1440x1080. Wide-field fundus photograph from neonatal ROP screening — 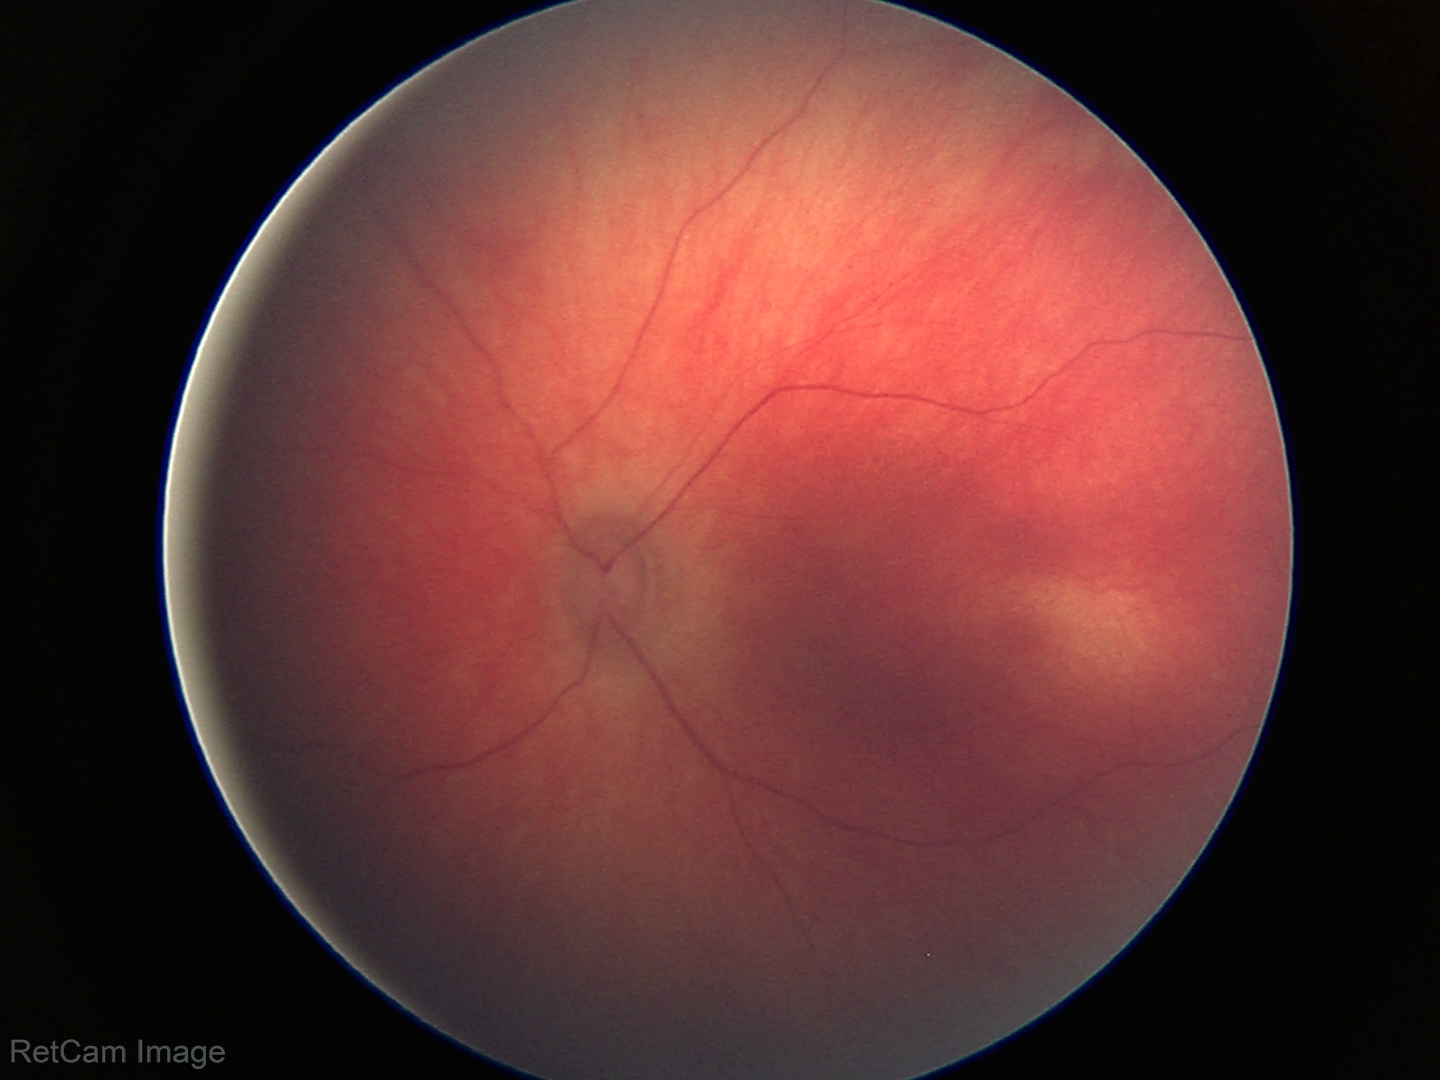

Assessment: physiological finding.